Diabetic retinopathy graded by the modified Davis classification:
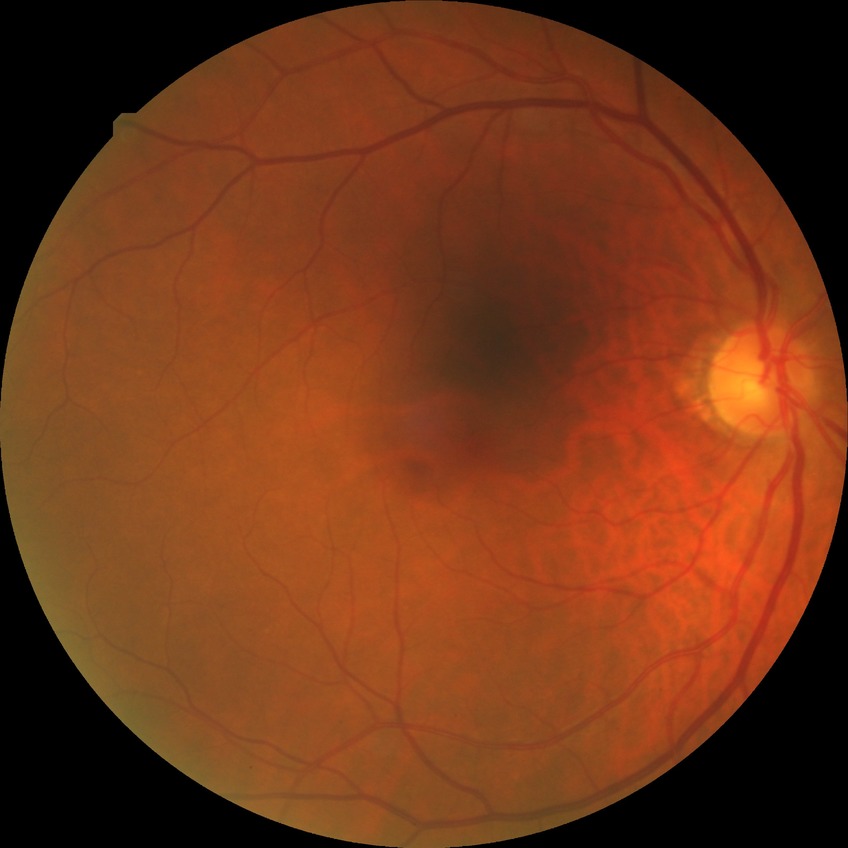 Retinopathy grade is no diabetic retinopathy.